2346 by 1568 pixels
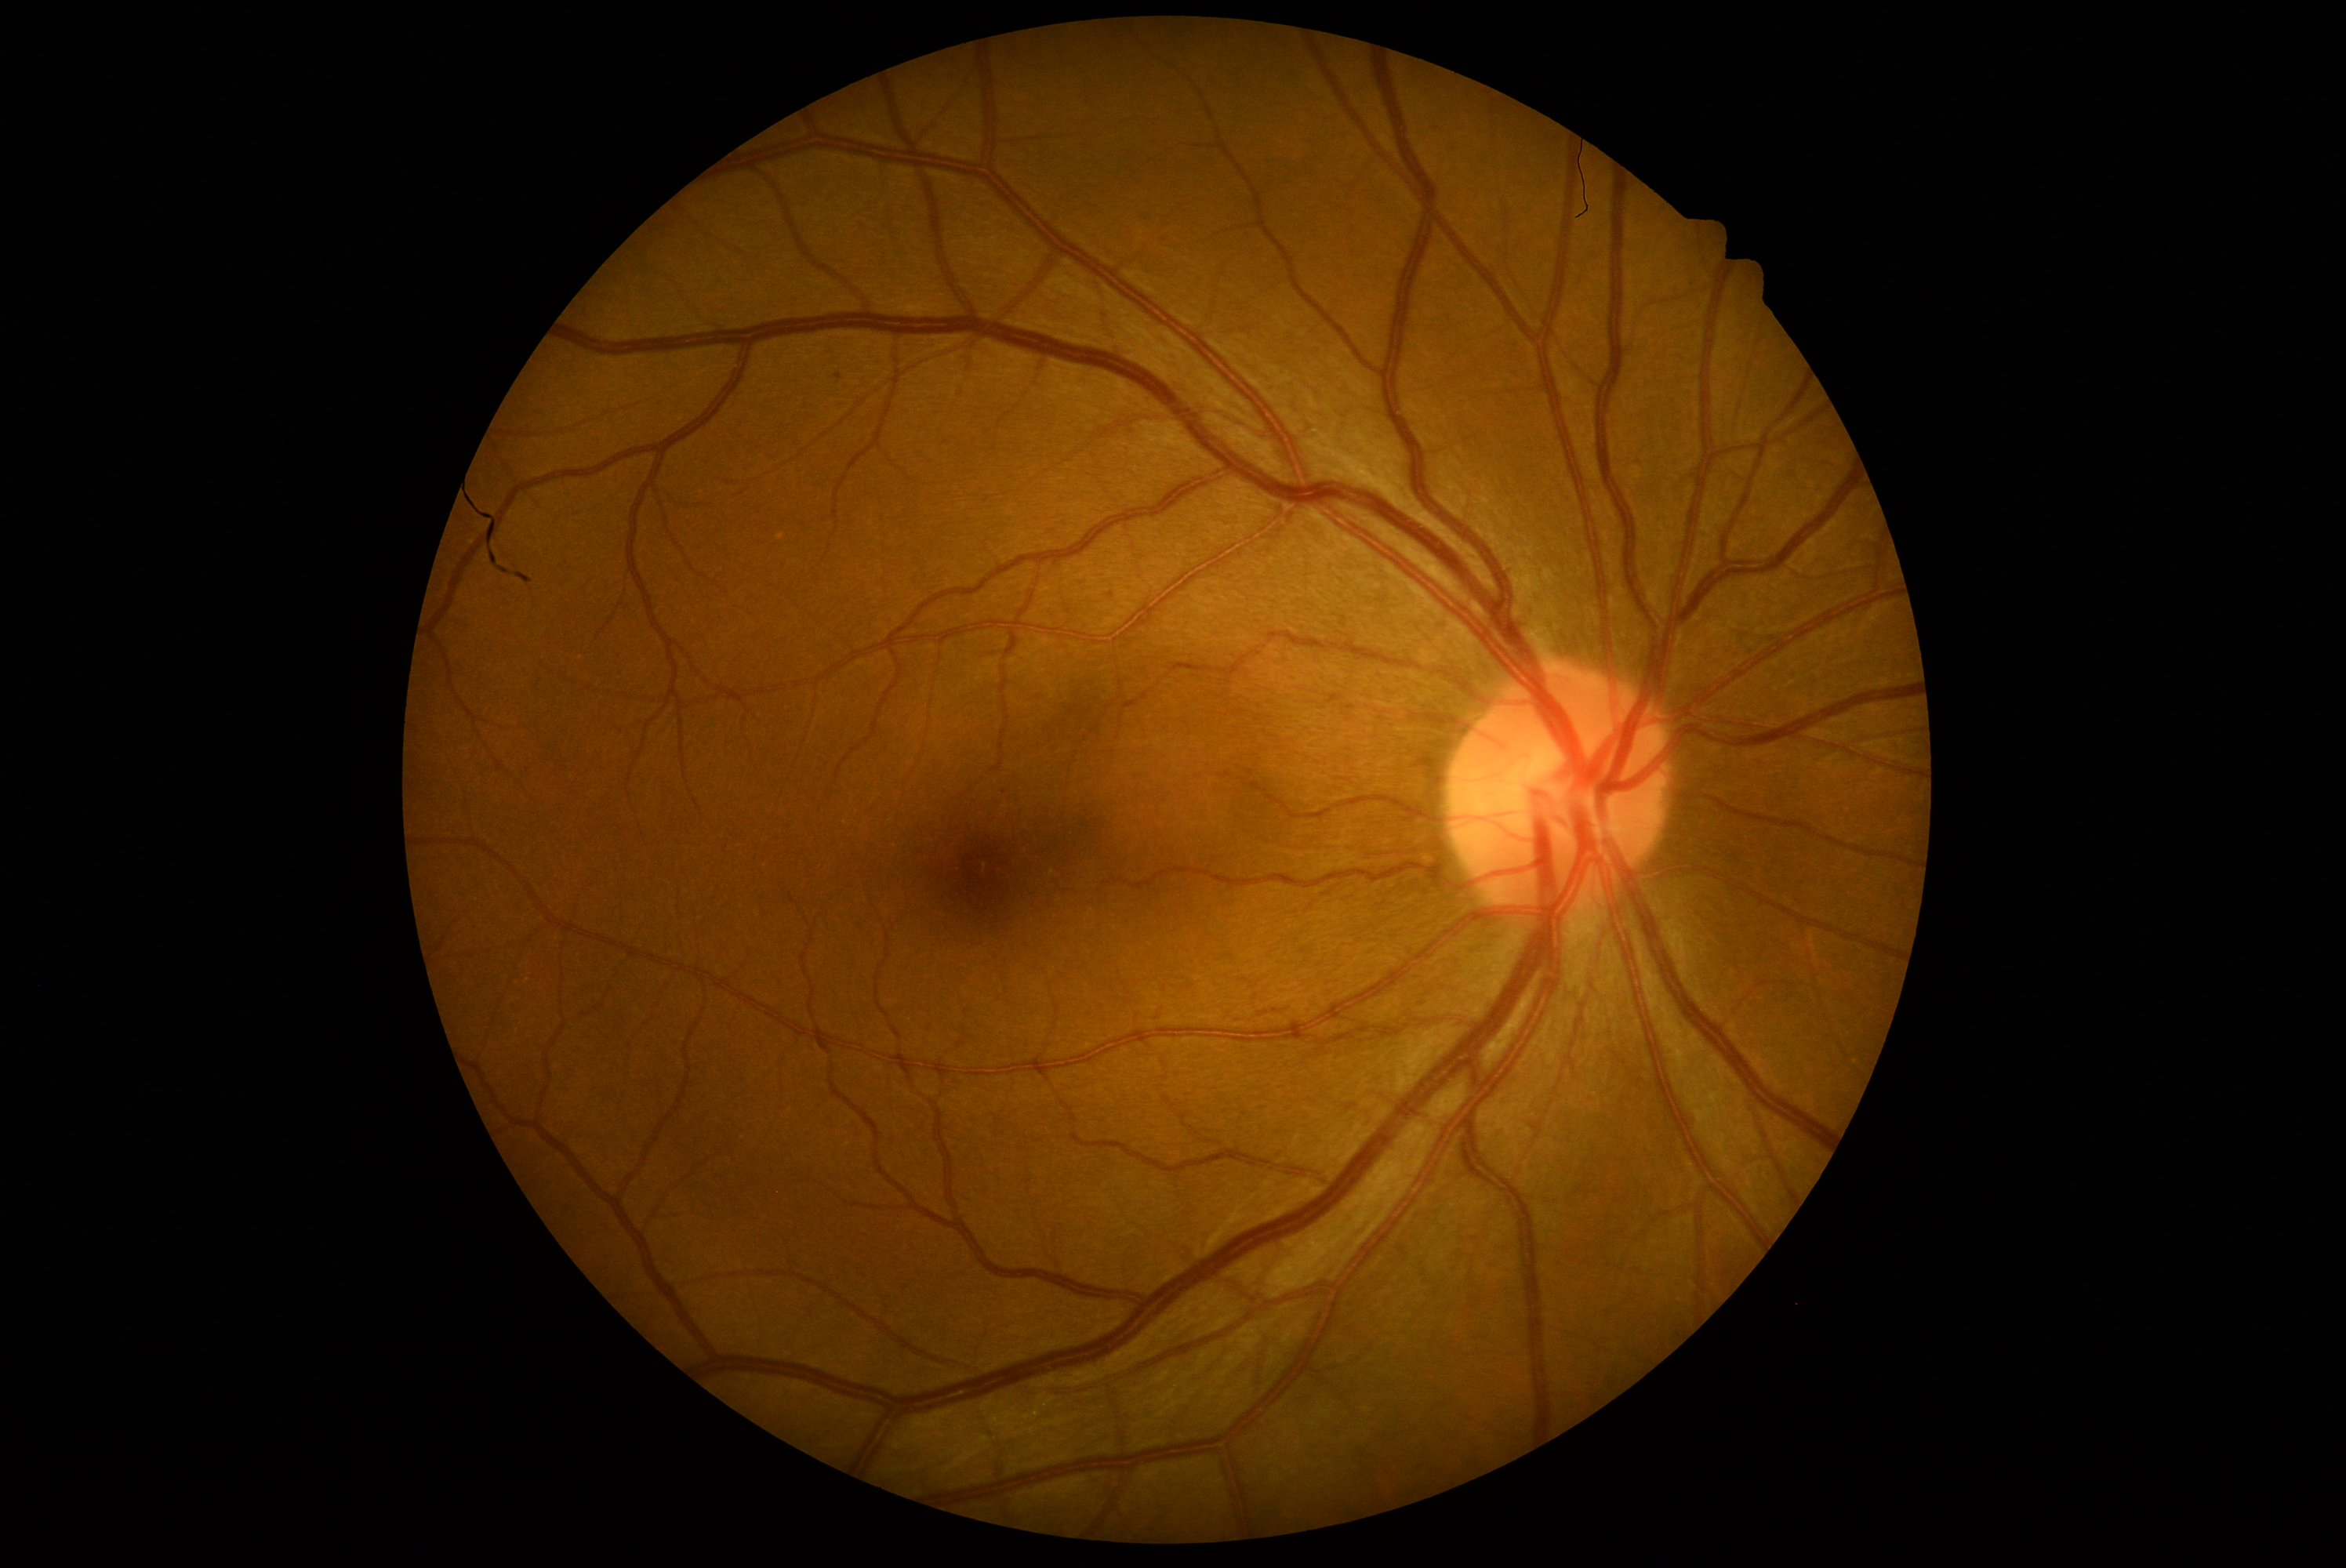 Diabetic retinopathy severity: mild non-proliferative diabetic retinopathy (grade 1) — presence of microaneurysms only.